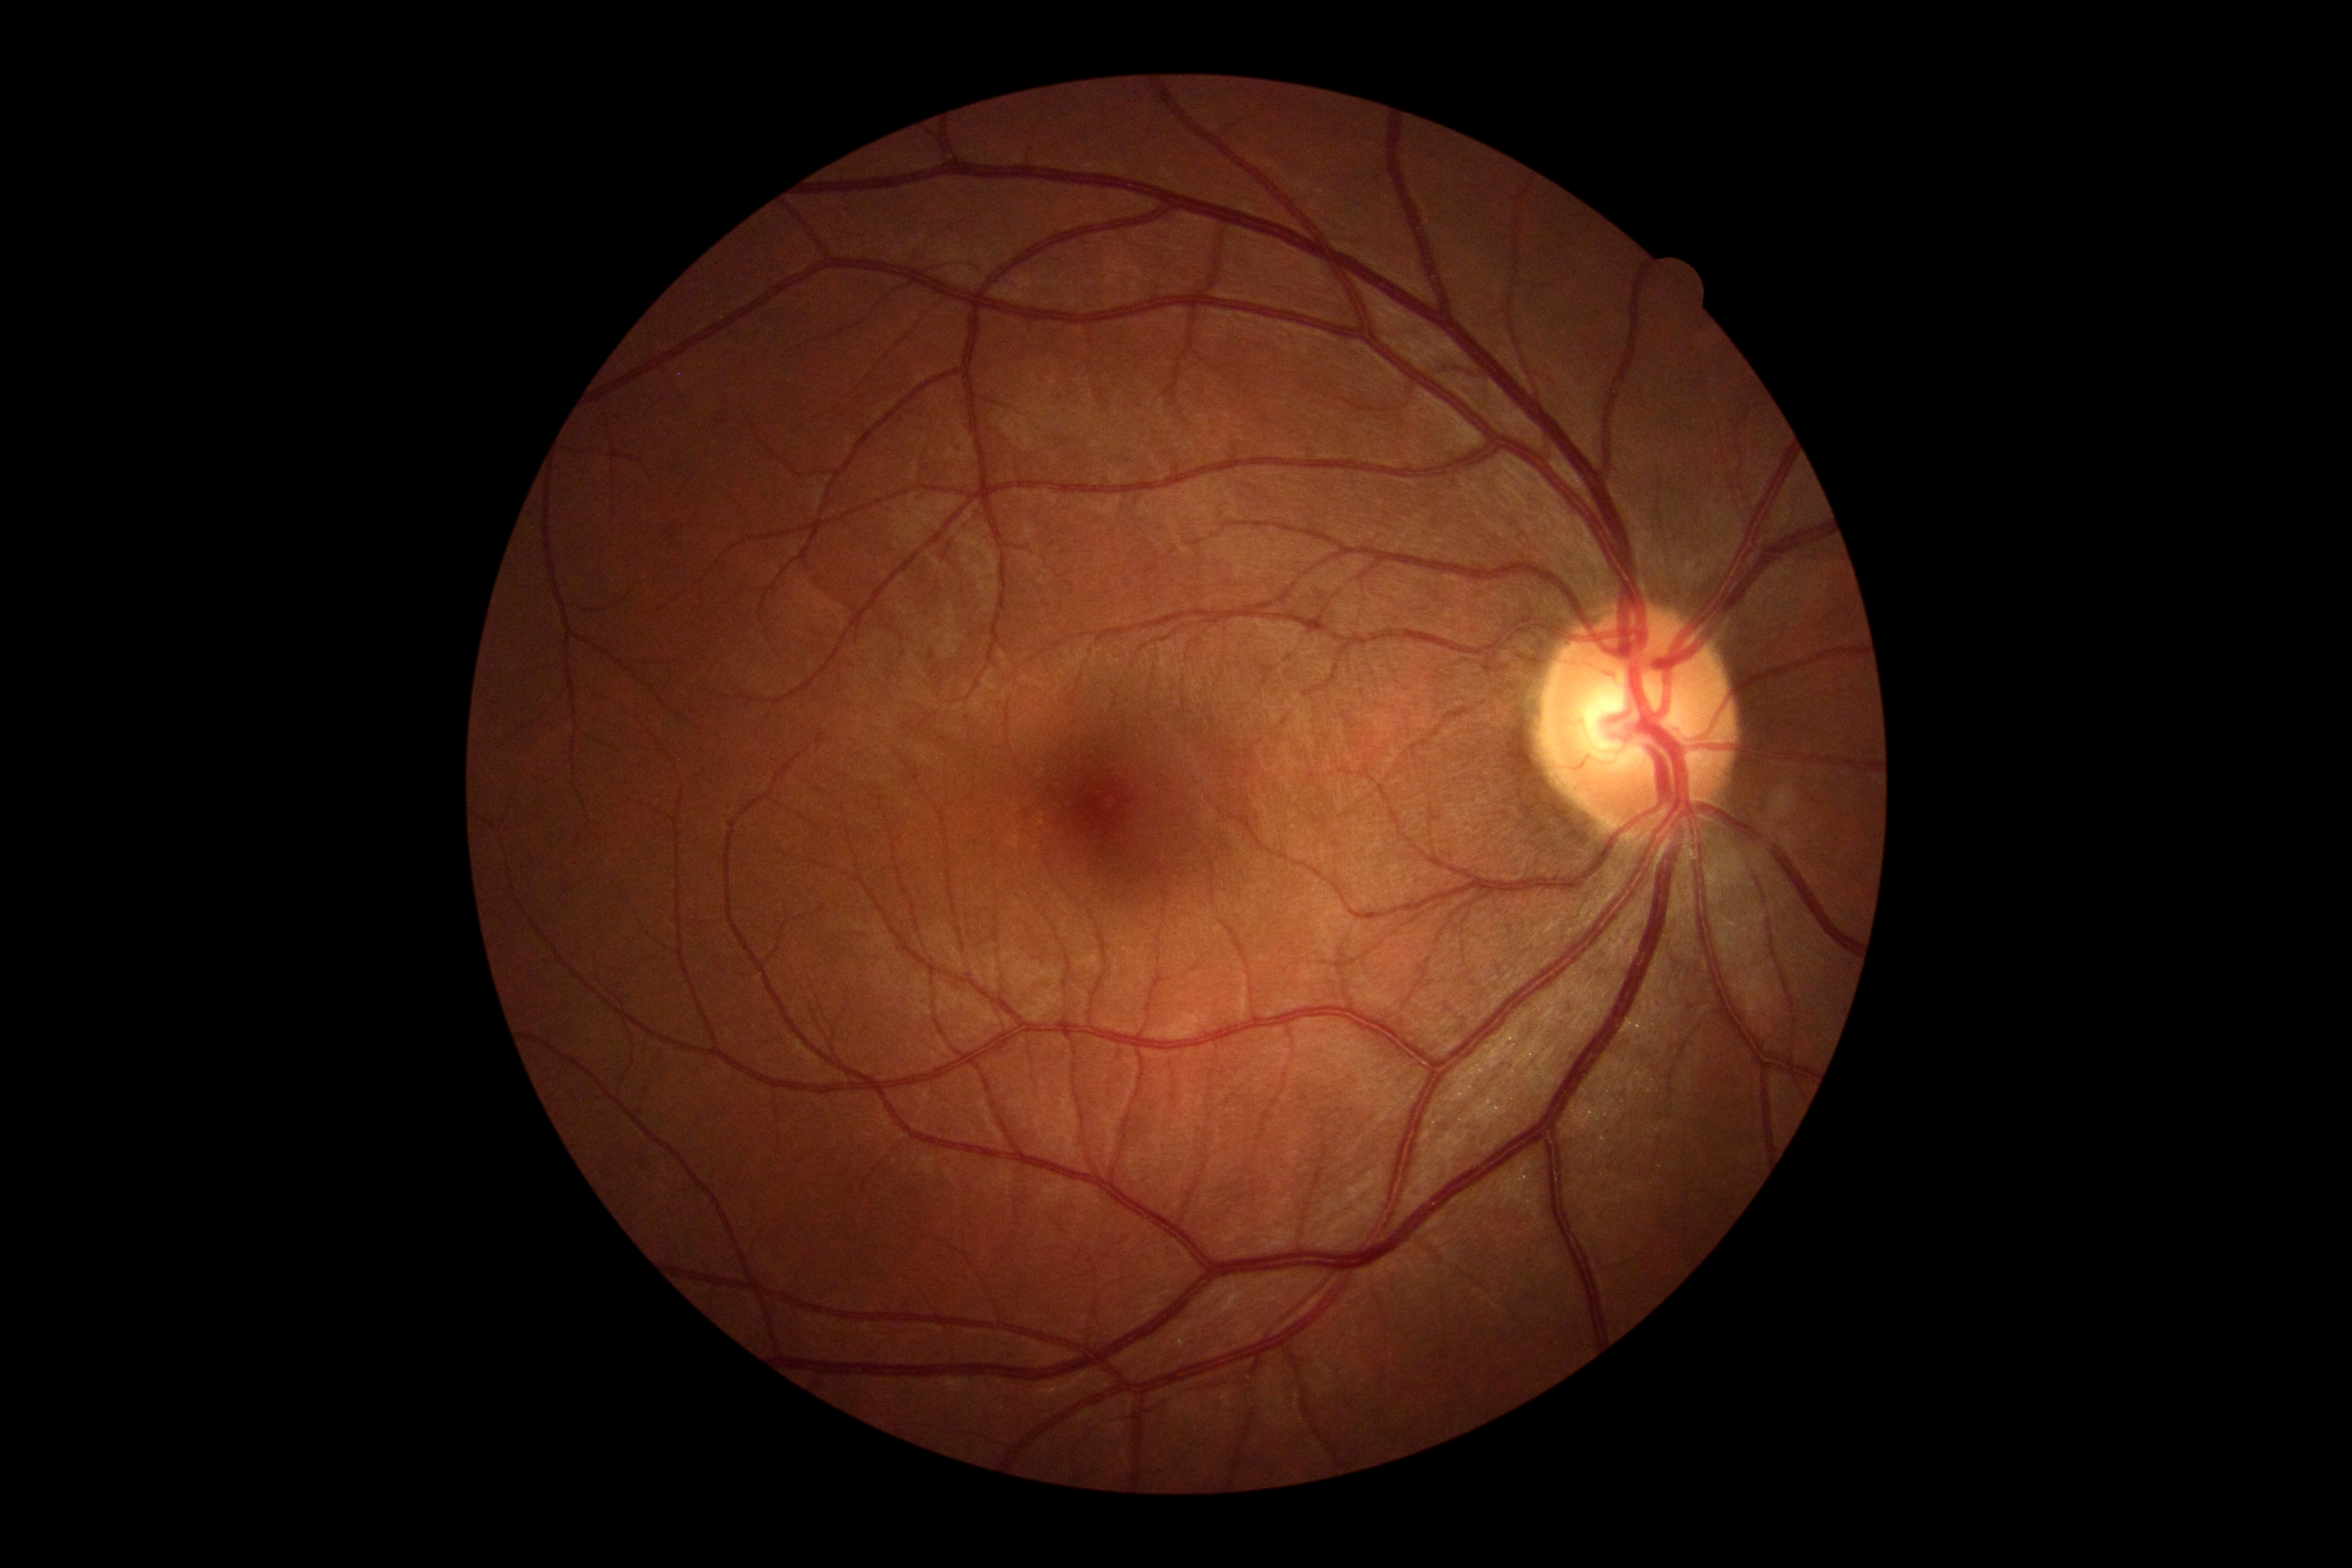
Retinopathy grade: 0.